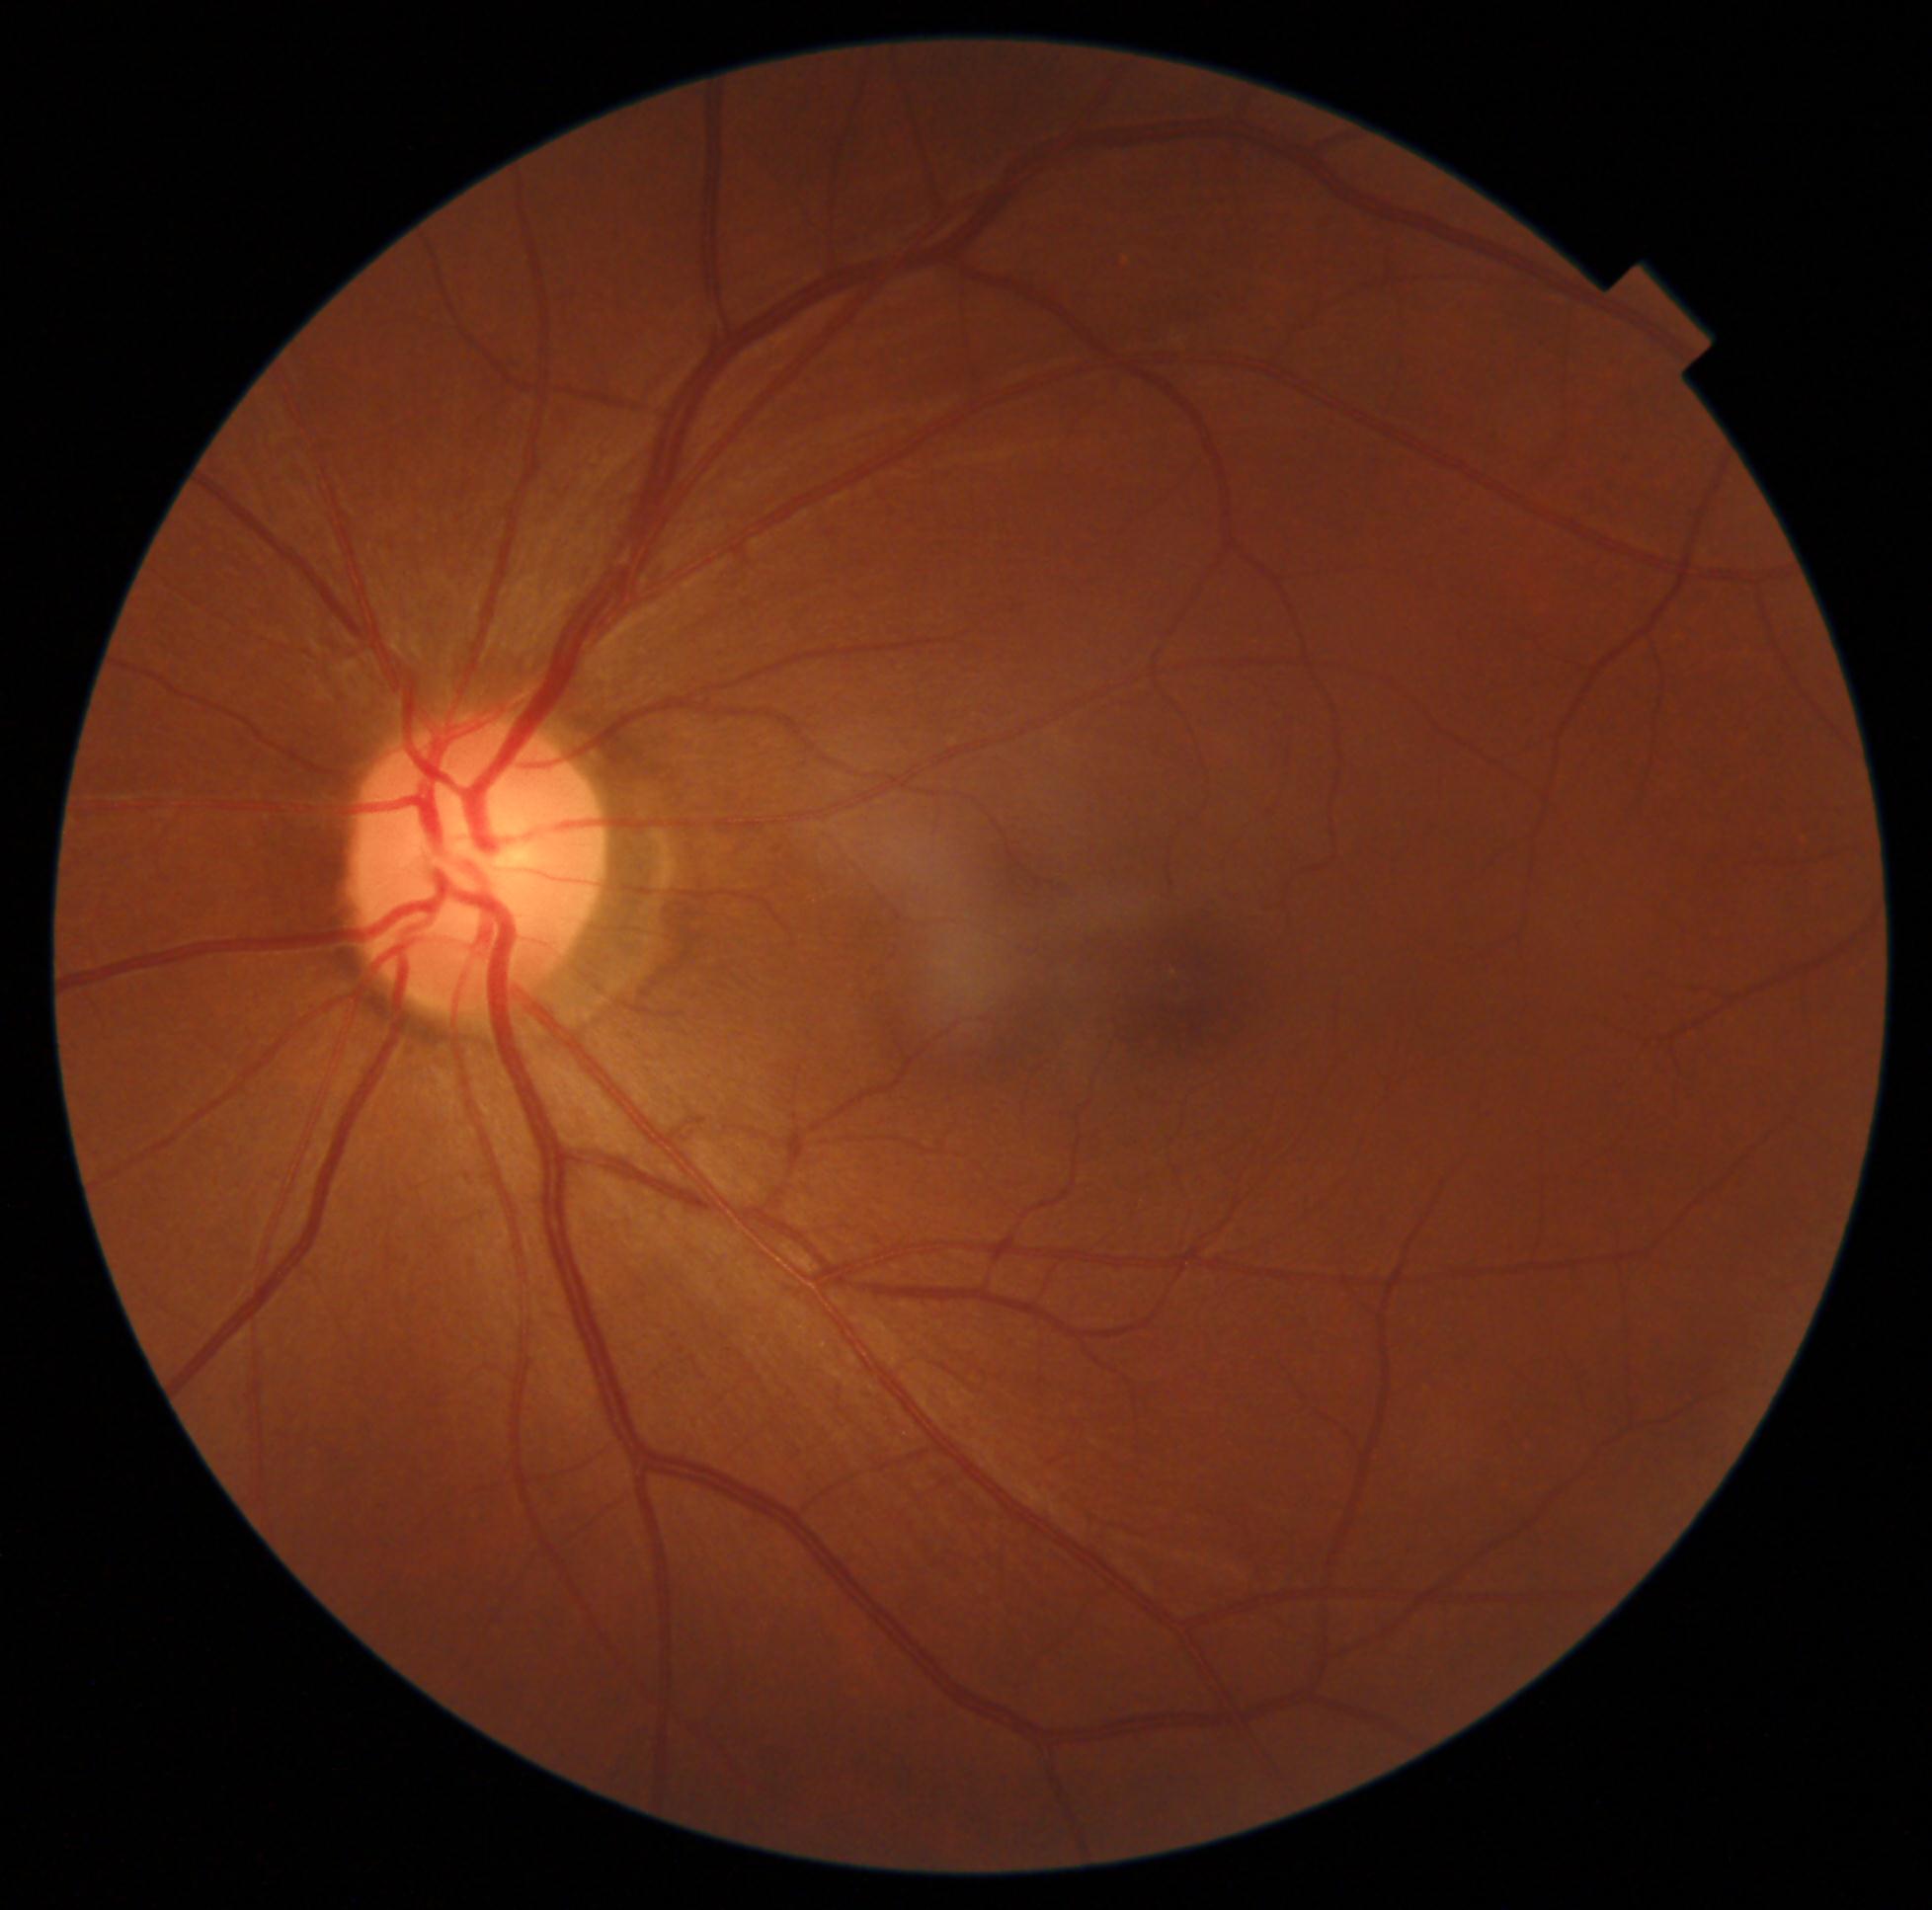

• DR severity — 0/4